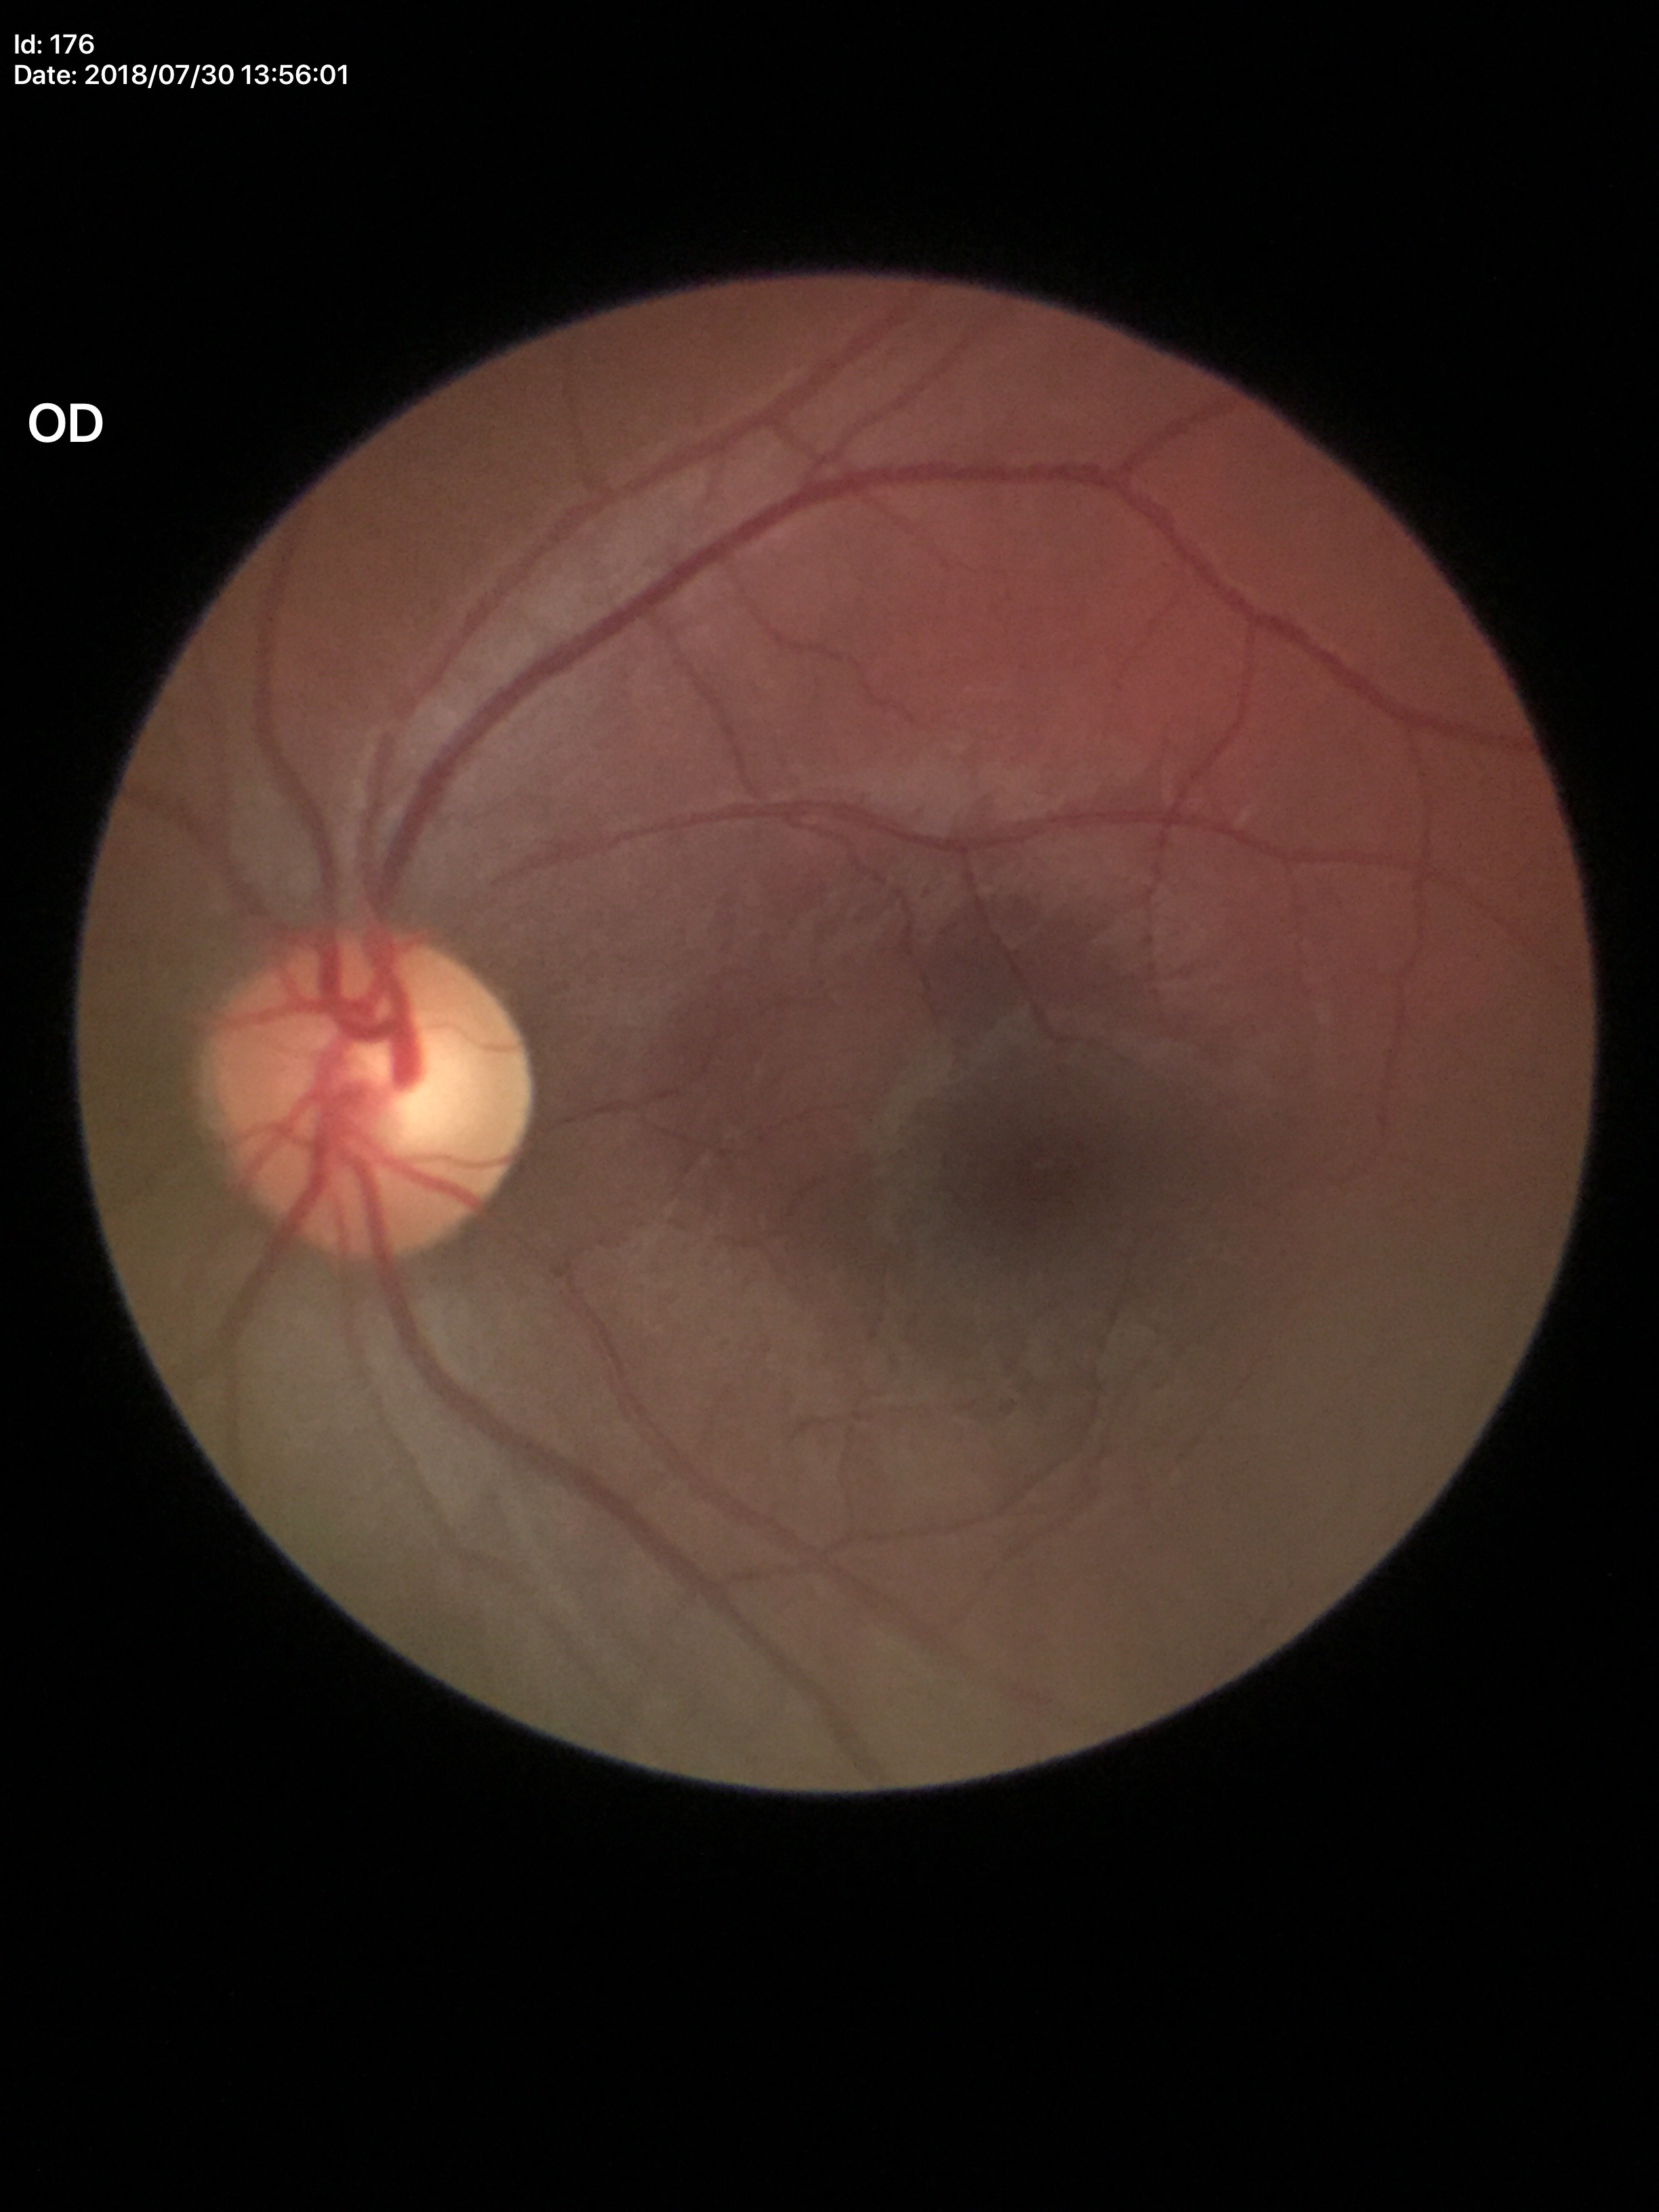
Glaucoma decision: not suspect.
Vertical CDR (VCDR) is 0.53.